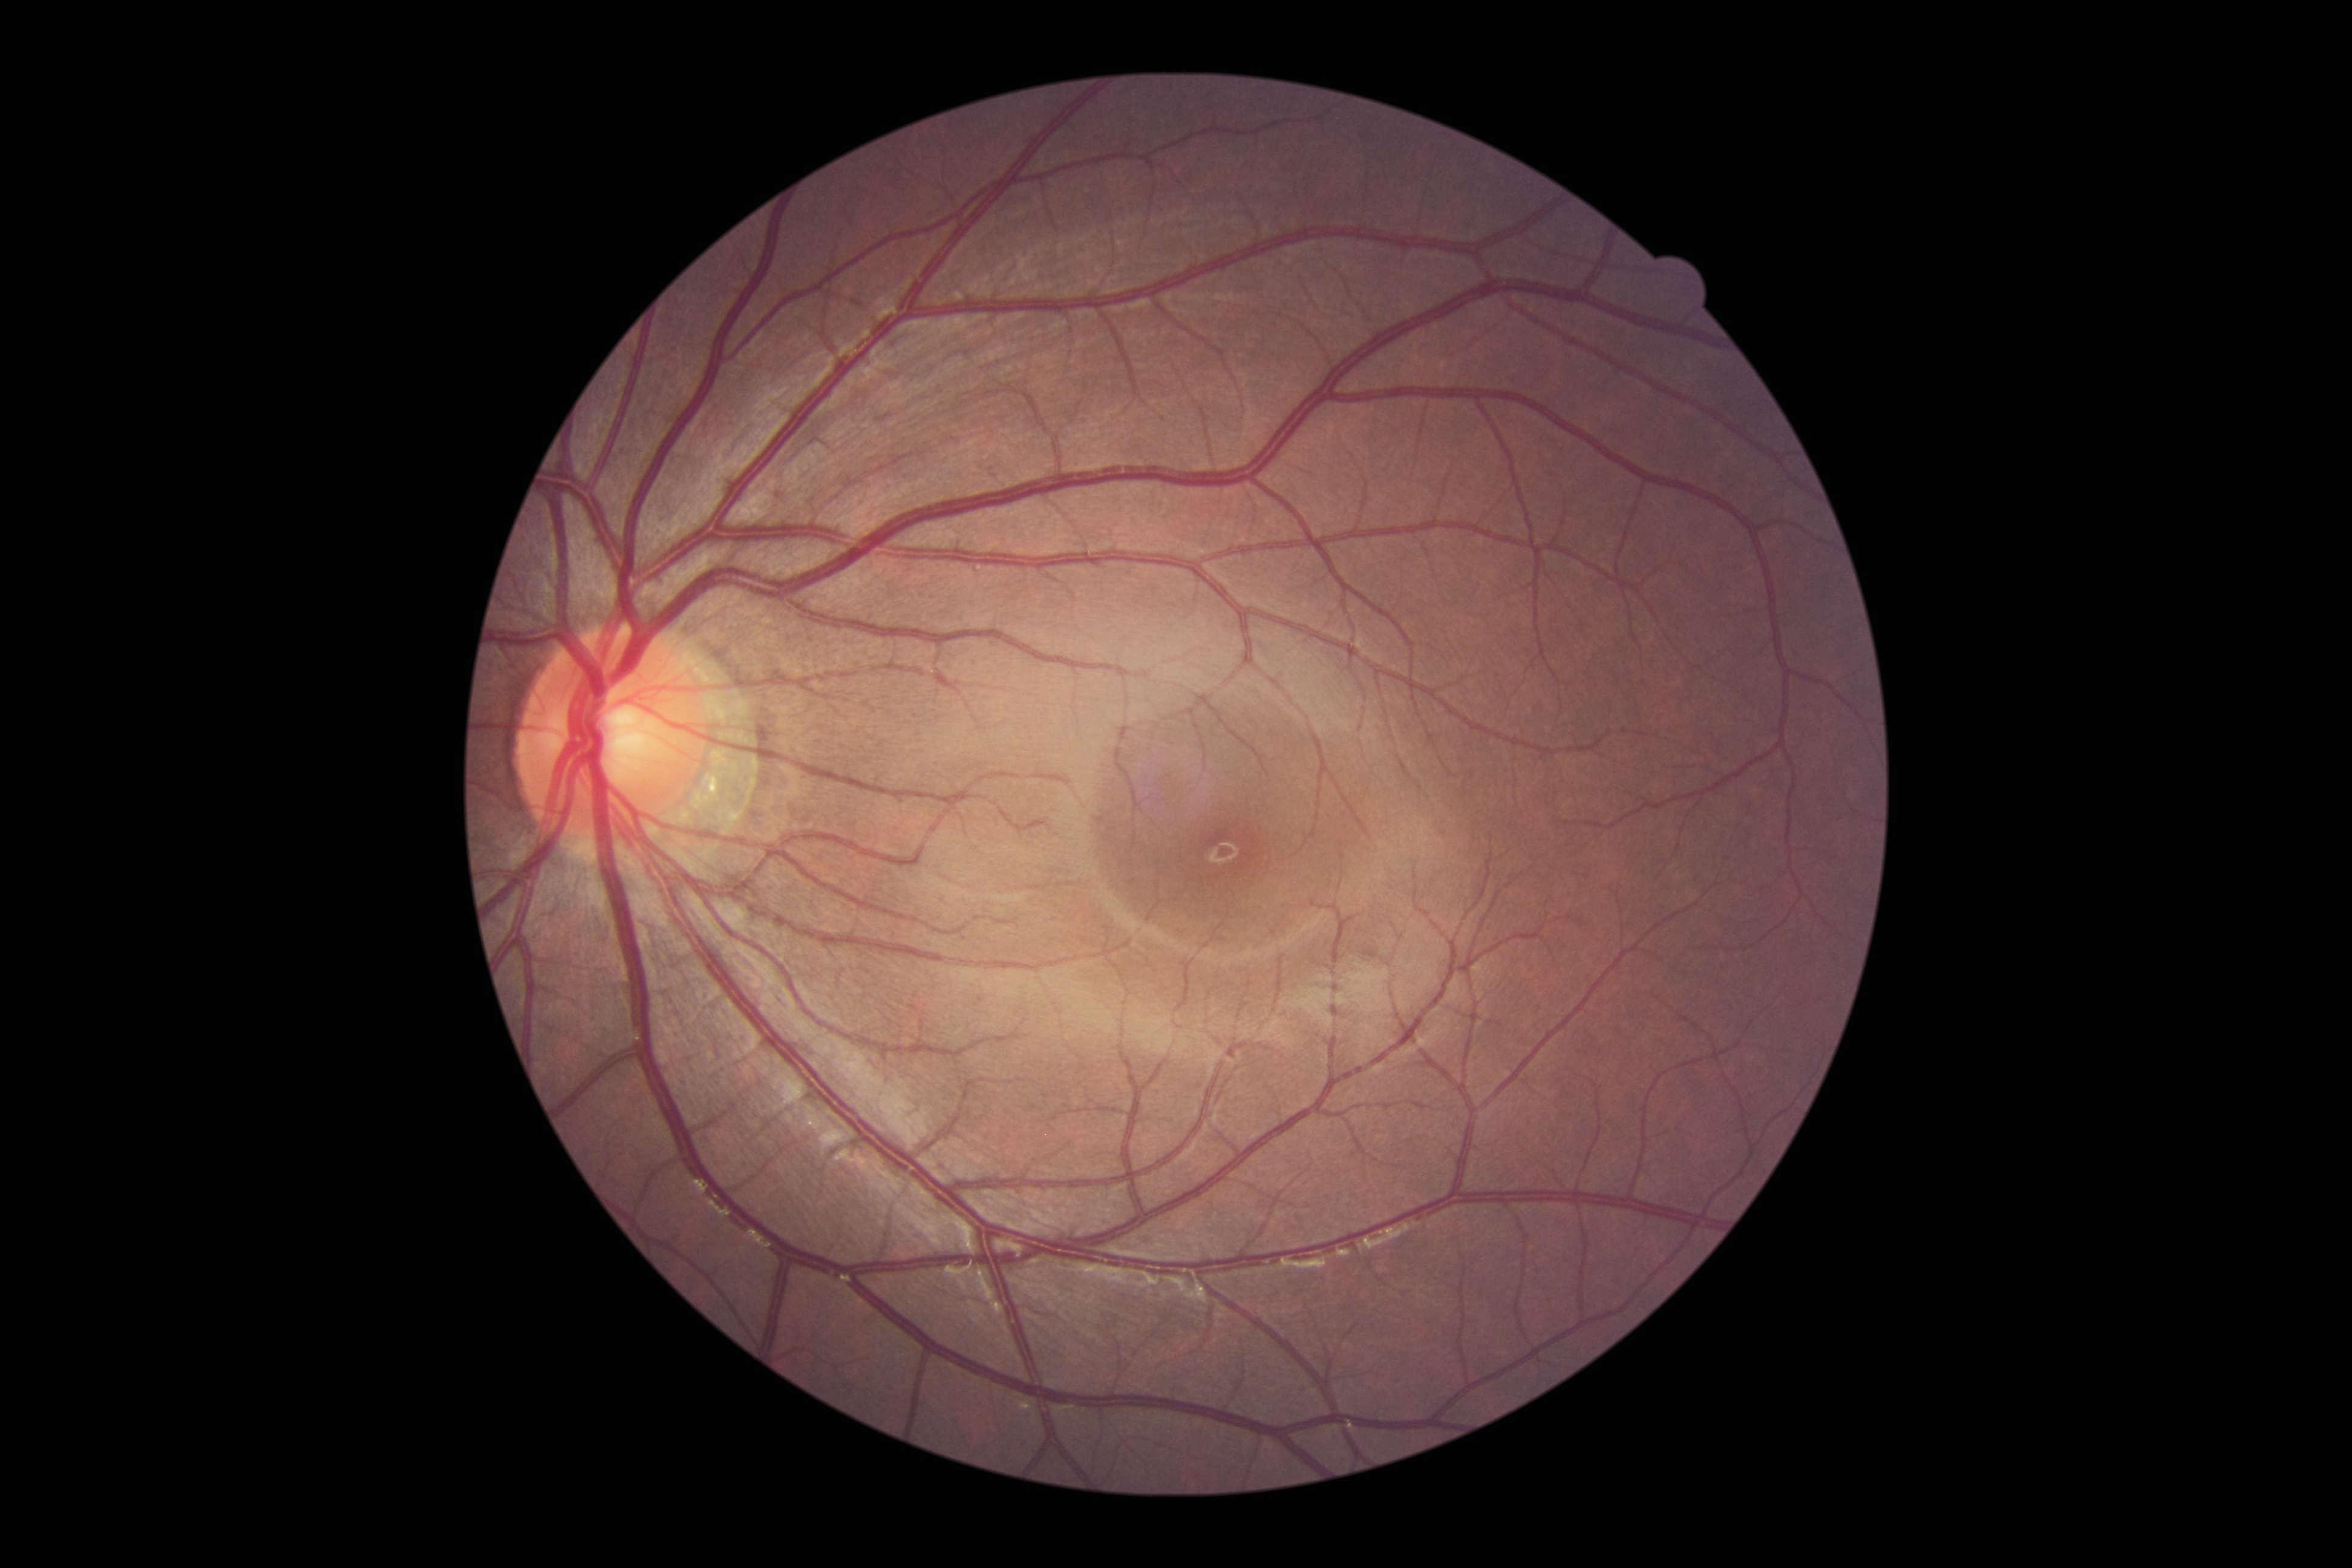 DR: 0.